Clarity RetCam 3, 130° FOV; pediatric retinal photograph (wide-field):
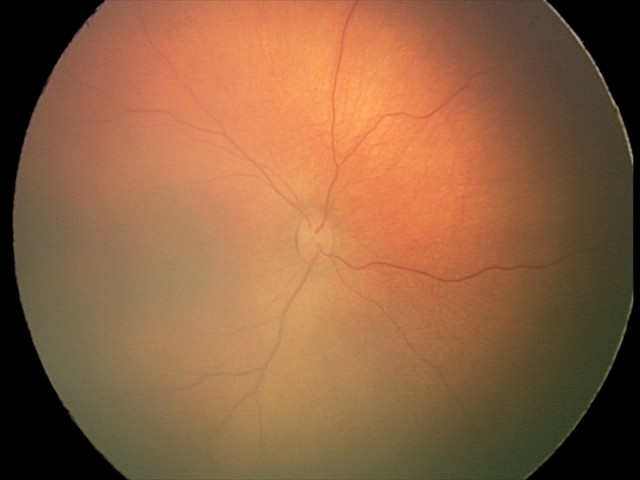 Examination with physiological retinal findings.